NIDEK AFC-230
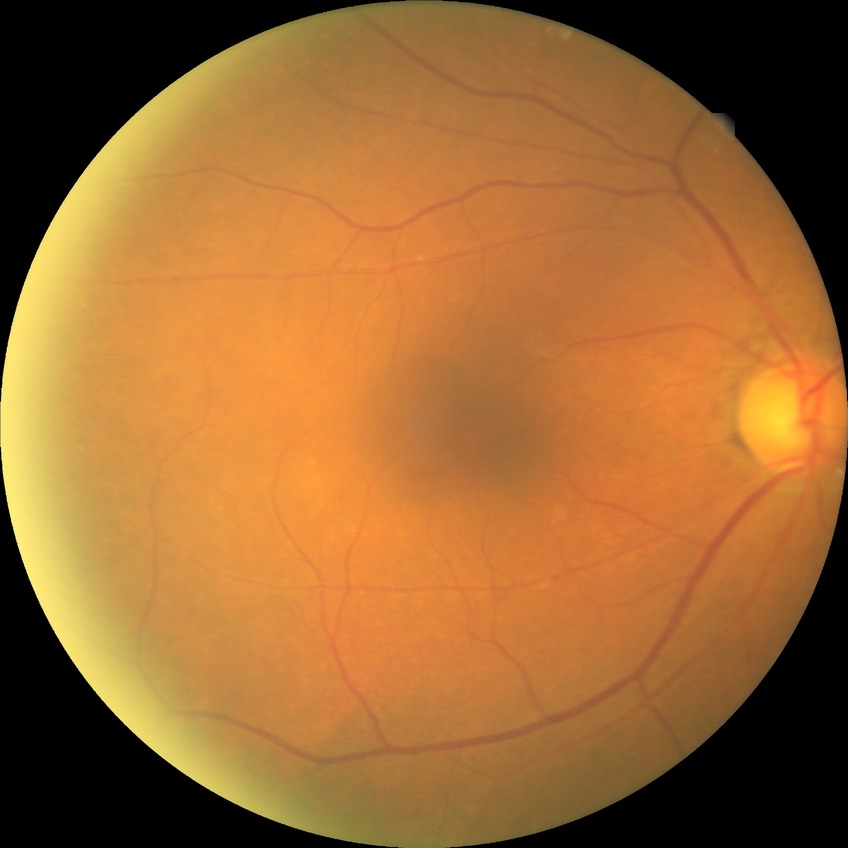

{
  "davis_grade": "NDR",
  "dr_impression": "no signs of DR"
}